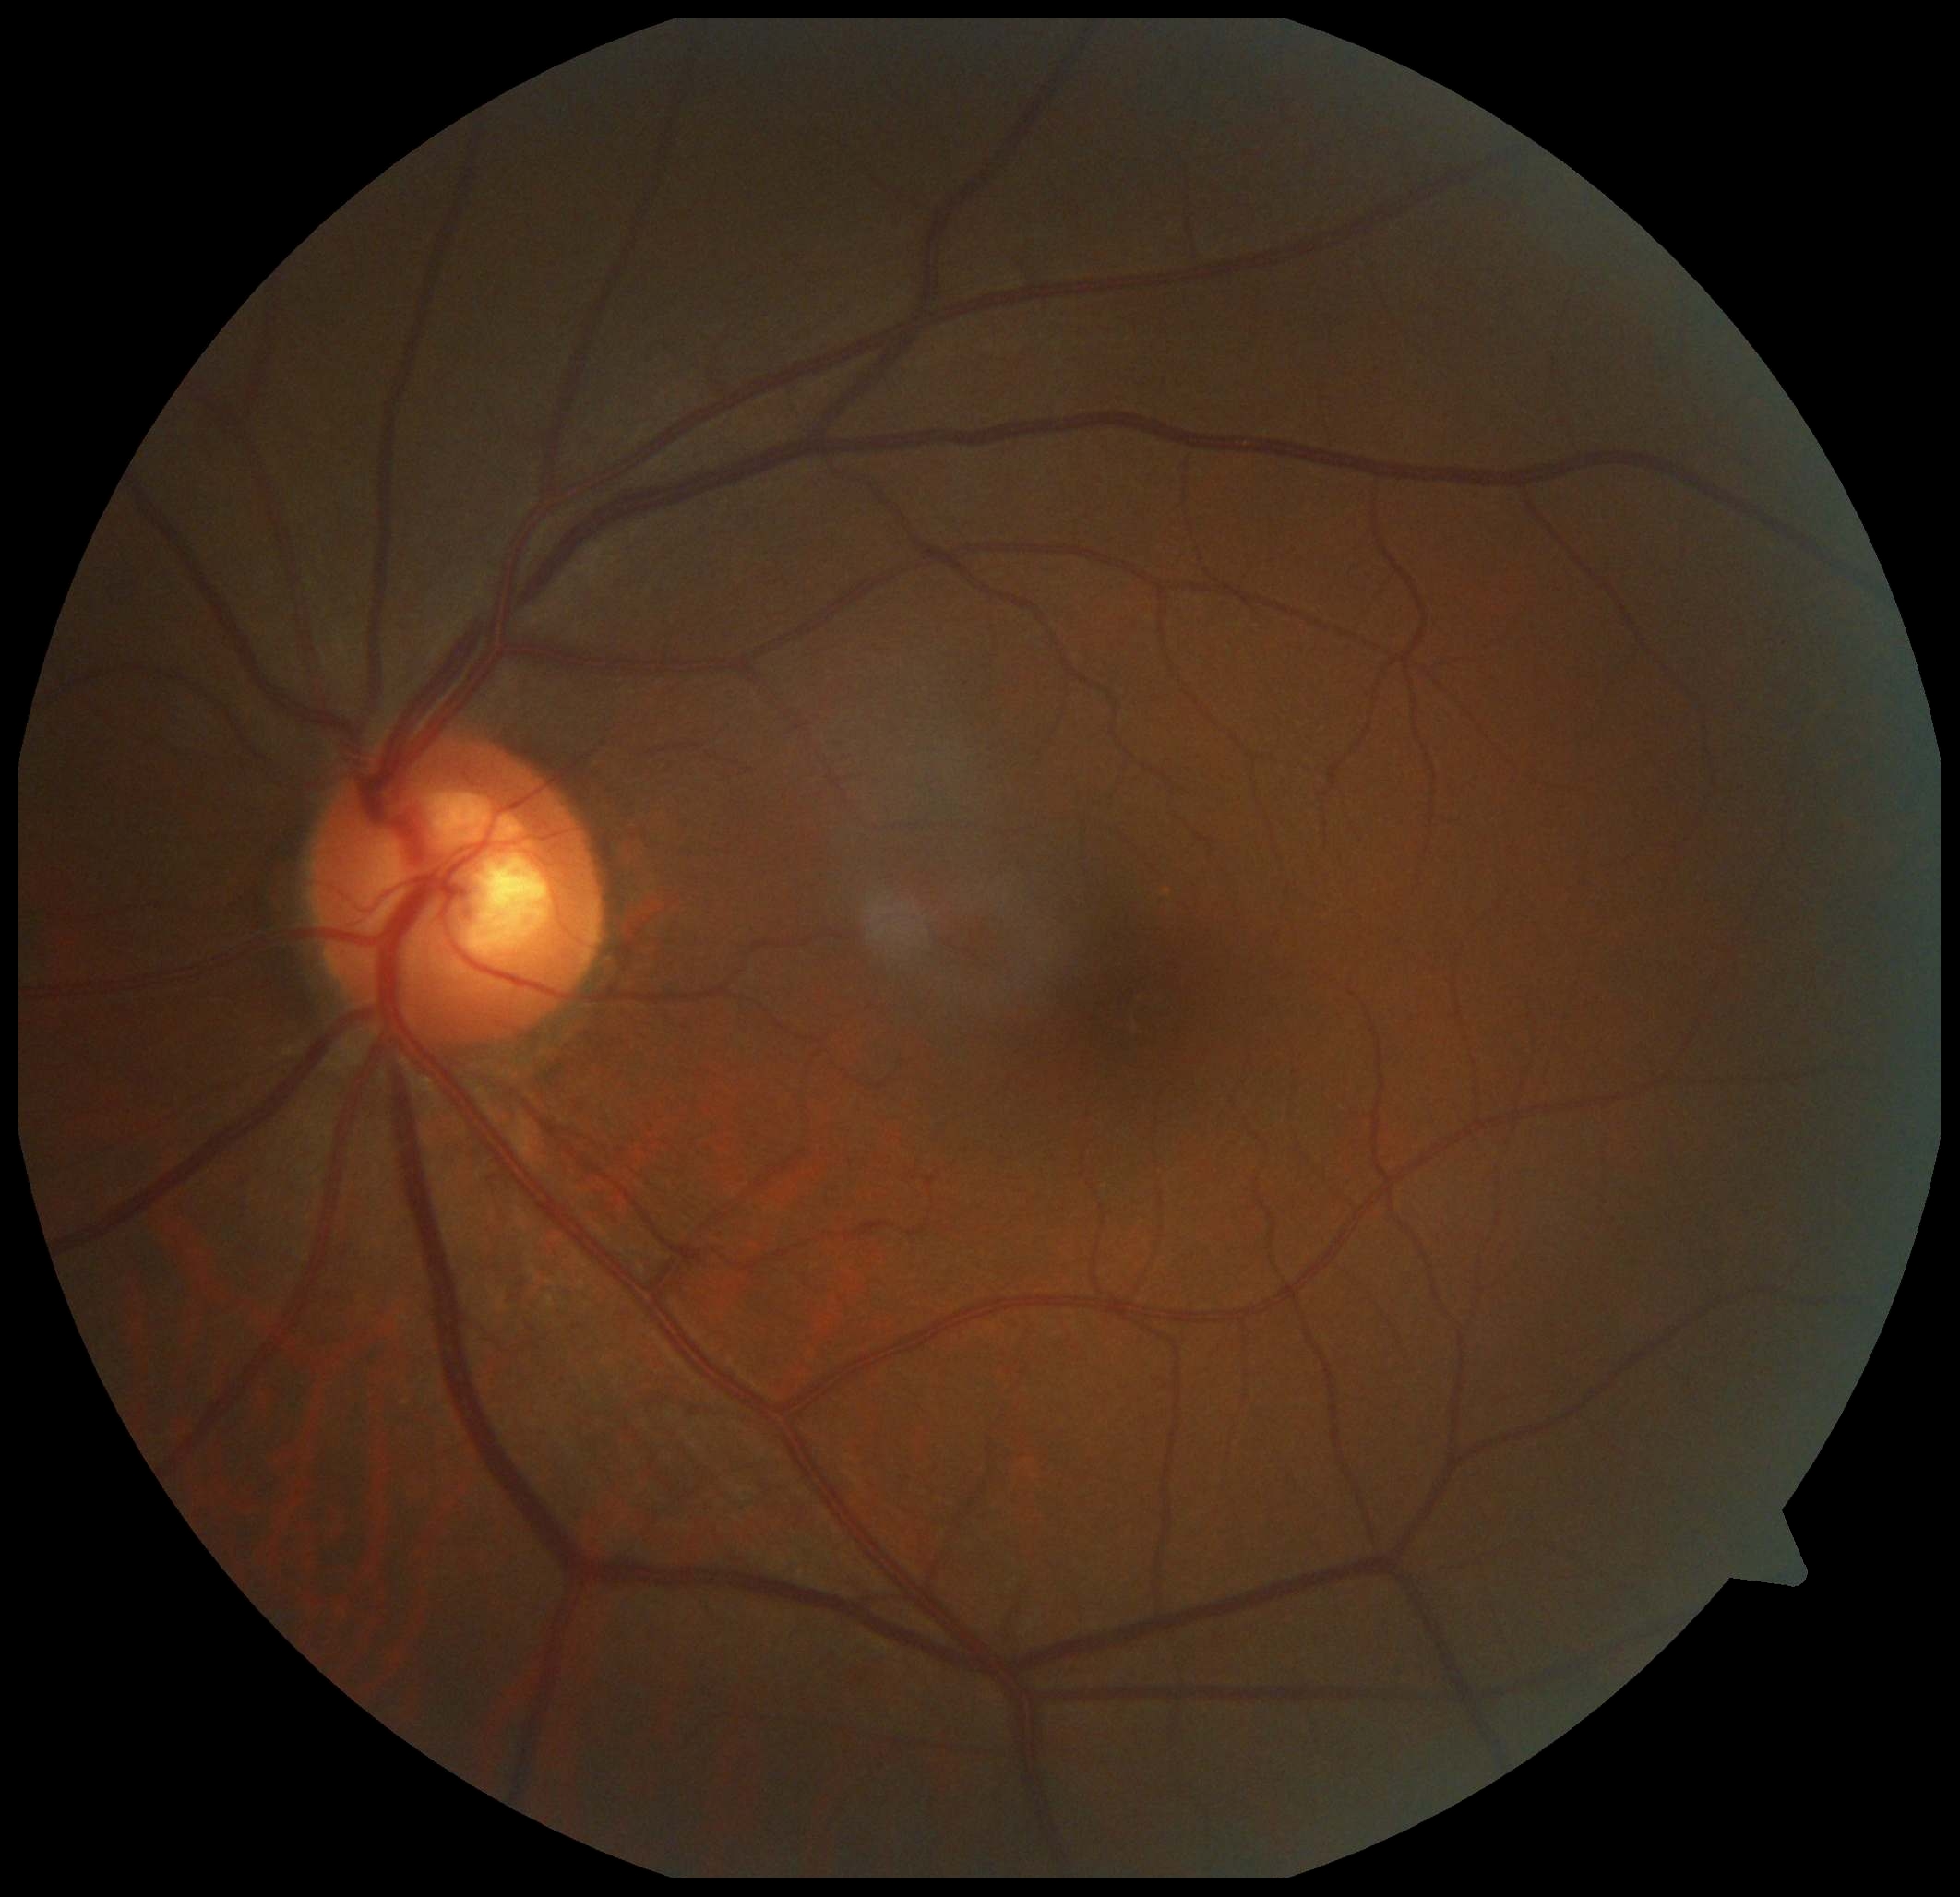

DR impression = no apparent DR
retinopathy = no apparent diabetic retinopathy (grade 0)